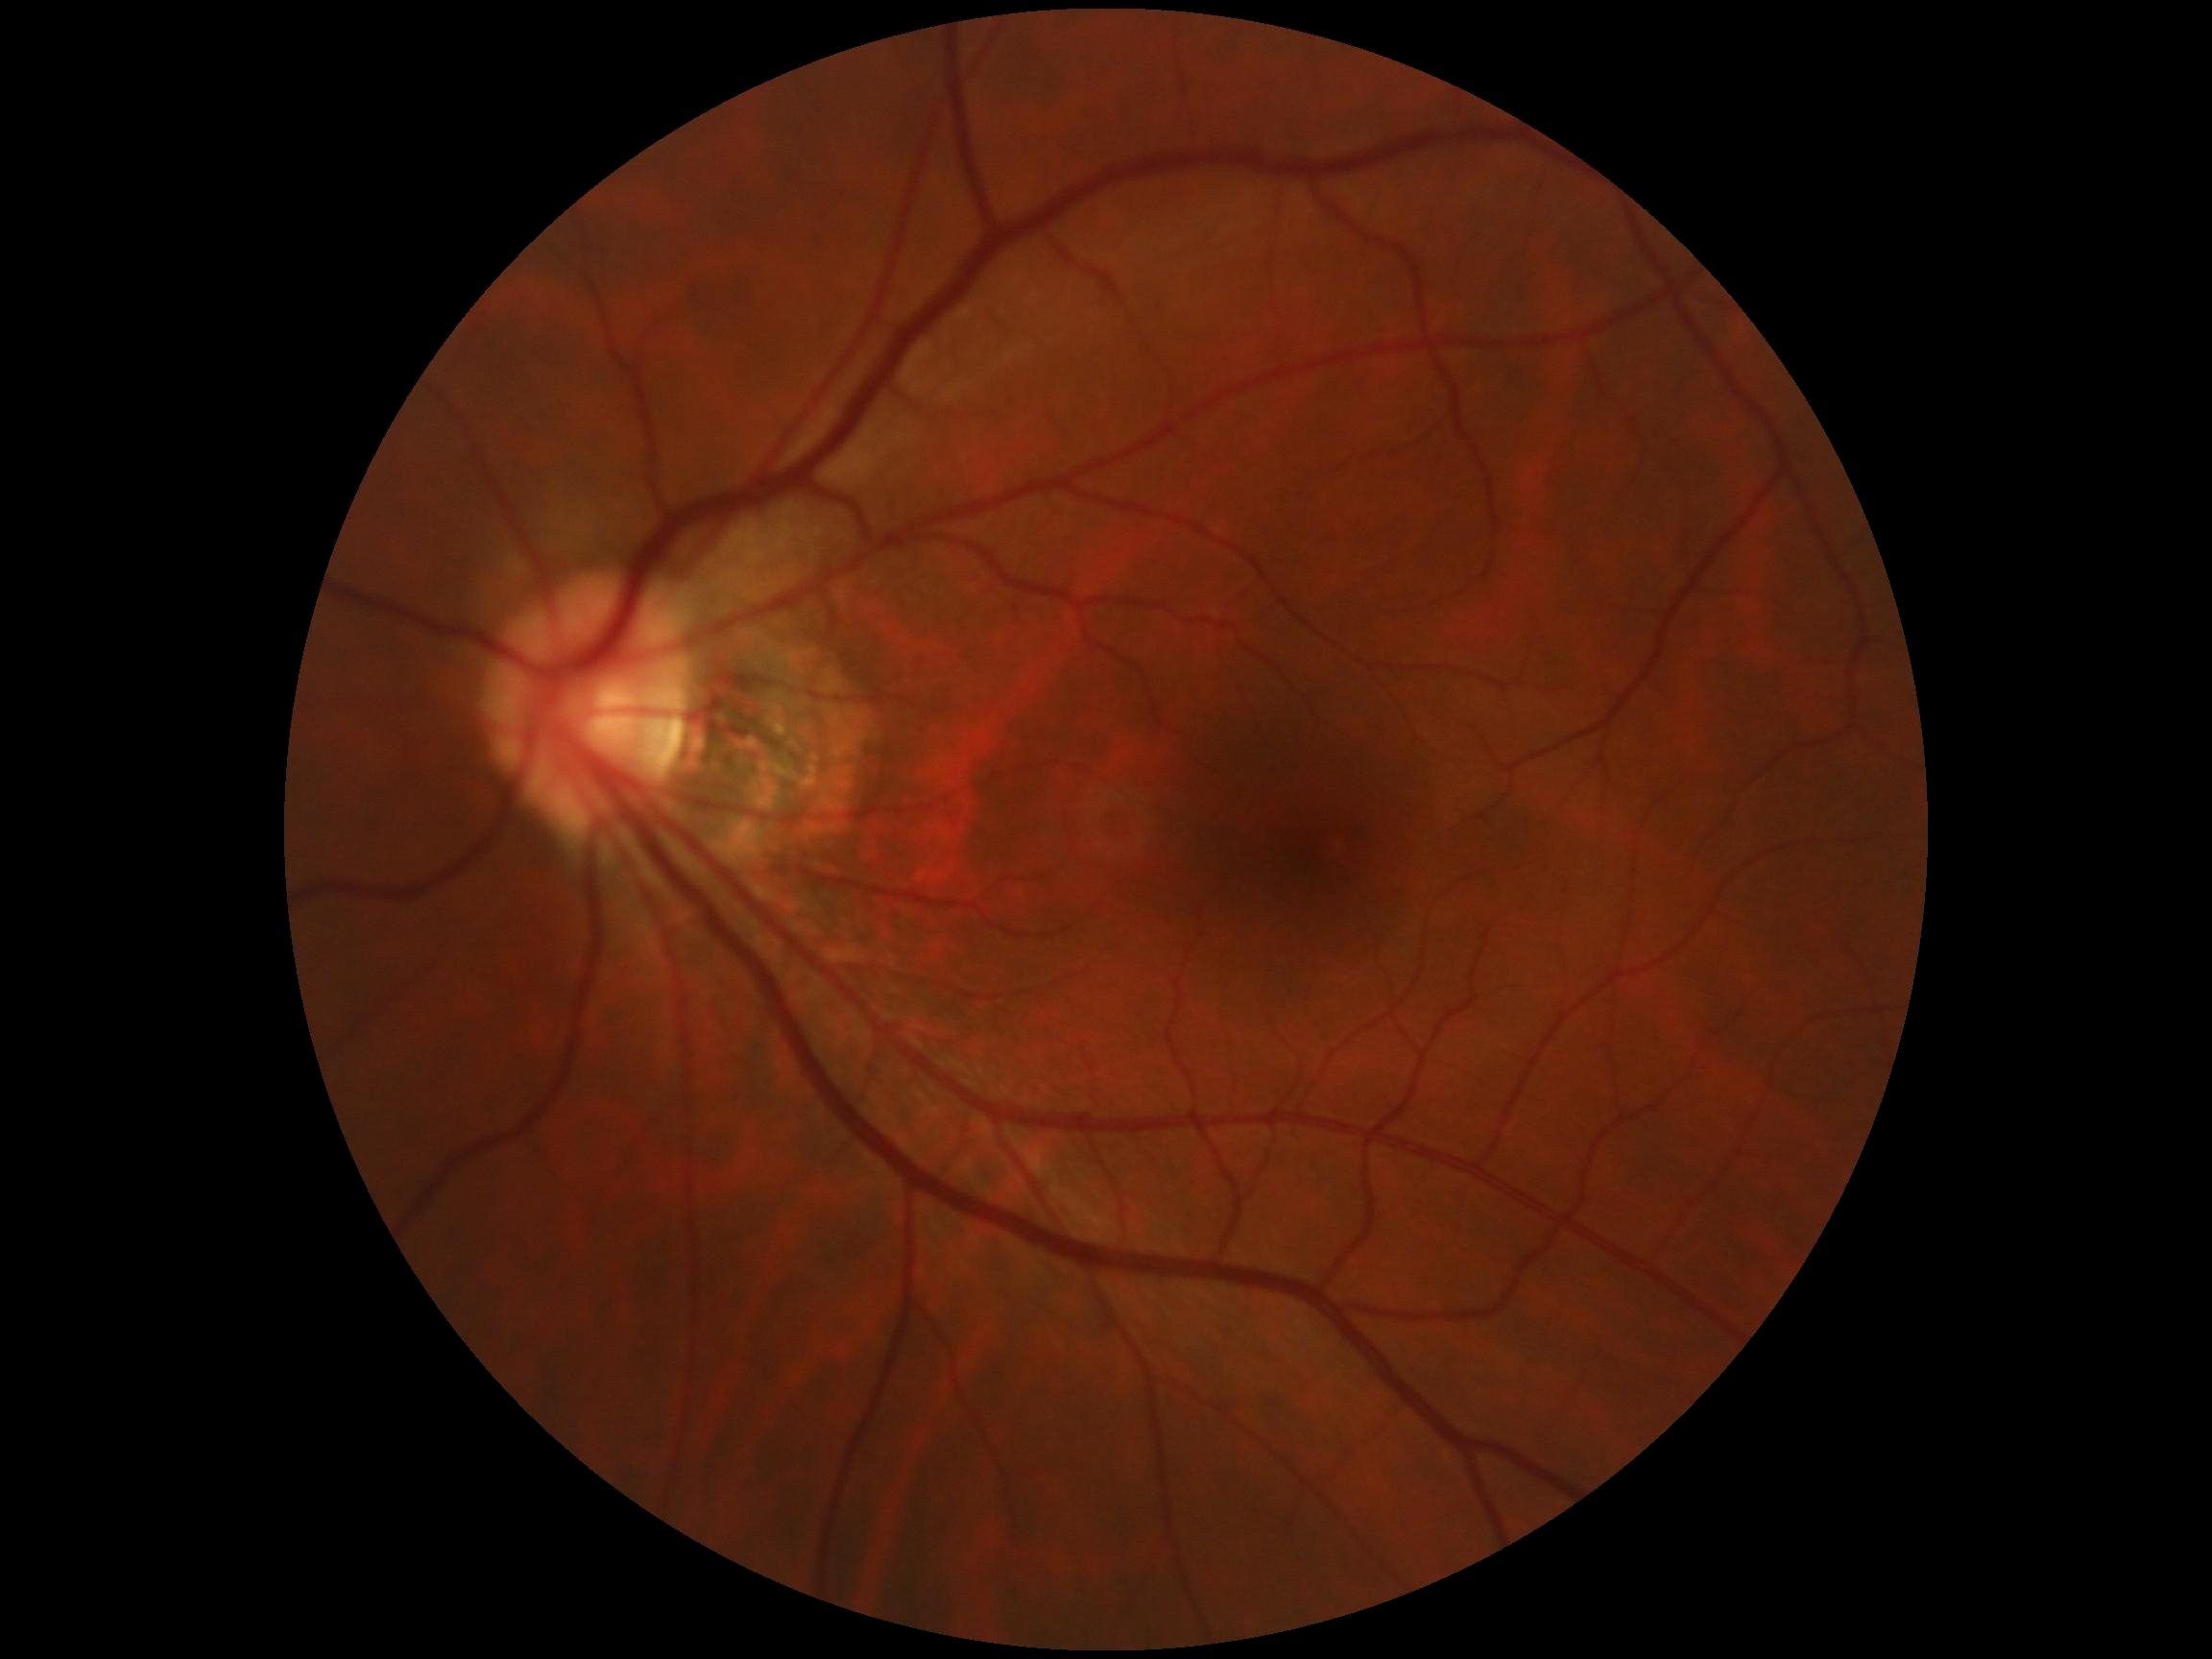

No apparent diabetic retinopathy.
Retinopathy: 0.